Wide-field retinal mosaic image
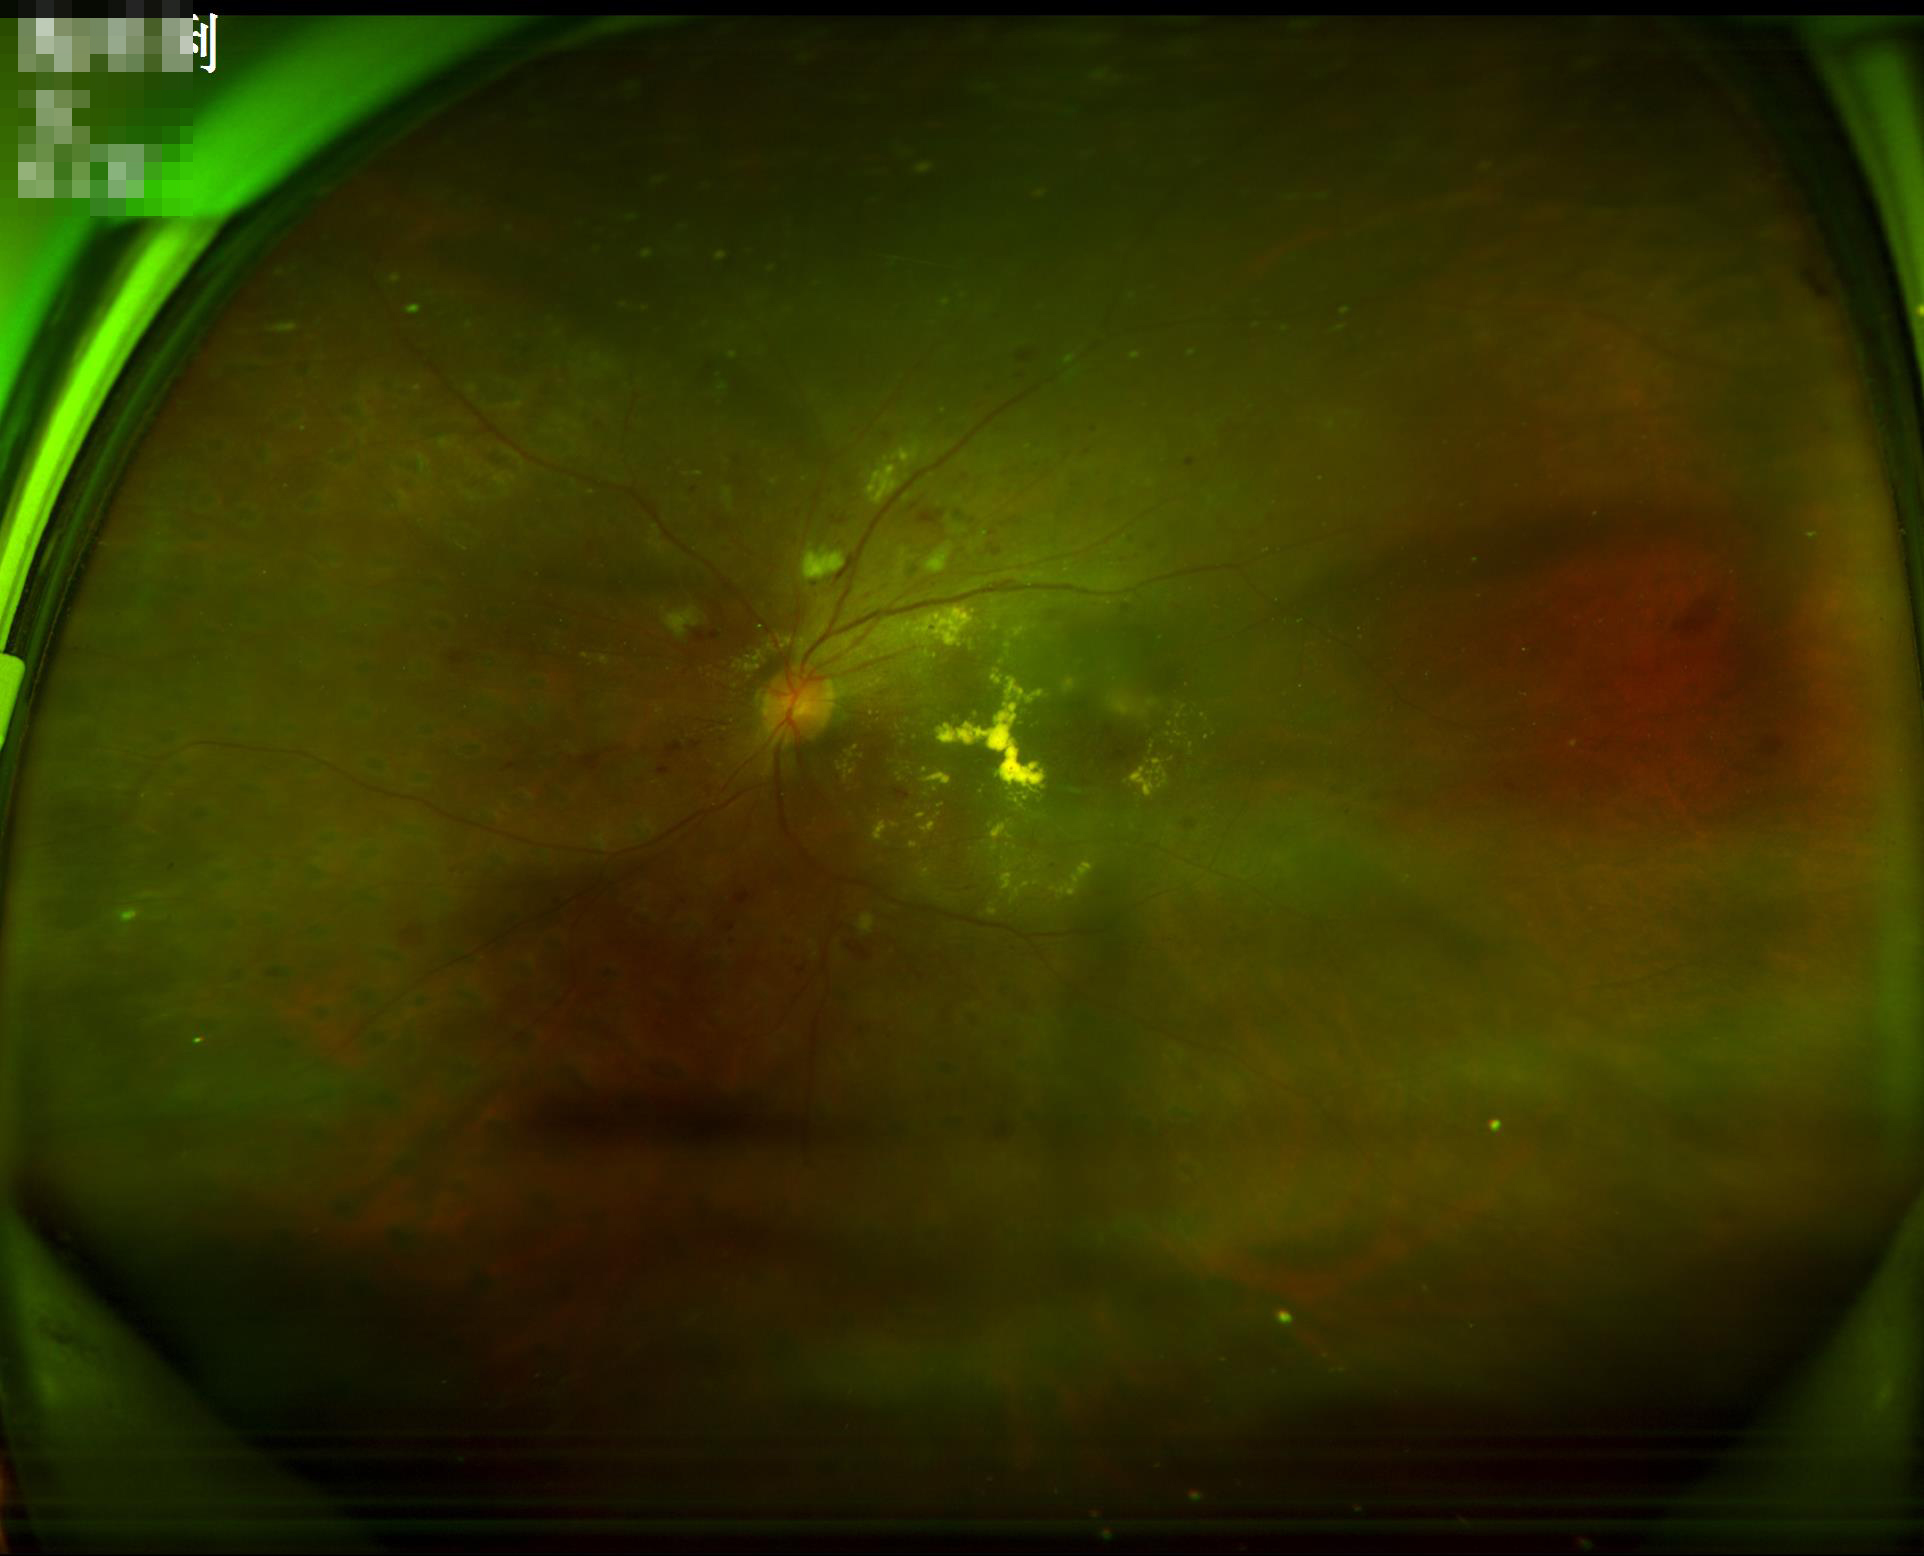
Poor illumination with uneven exposure.
The image is blurry.
Overall quality is poor; the image is difficult to grade.
Vessels and details are readily distinguishable.